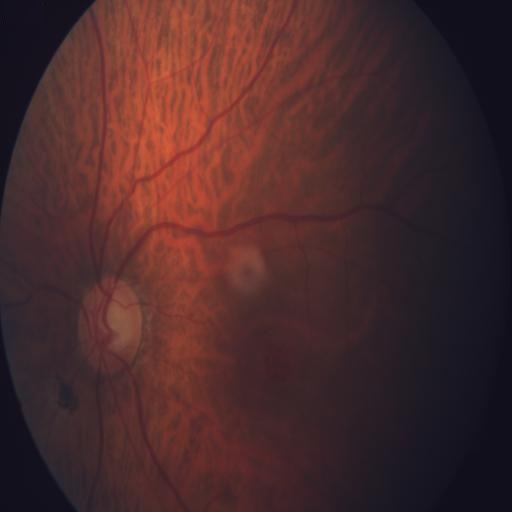
Findings consistent with optic disc cupping.